1240x1240px. Infant wide-field retinal image — 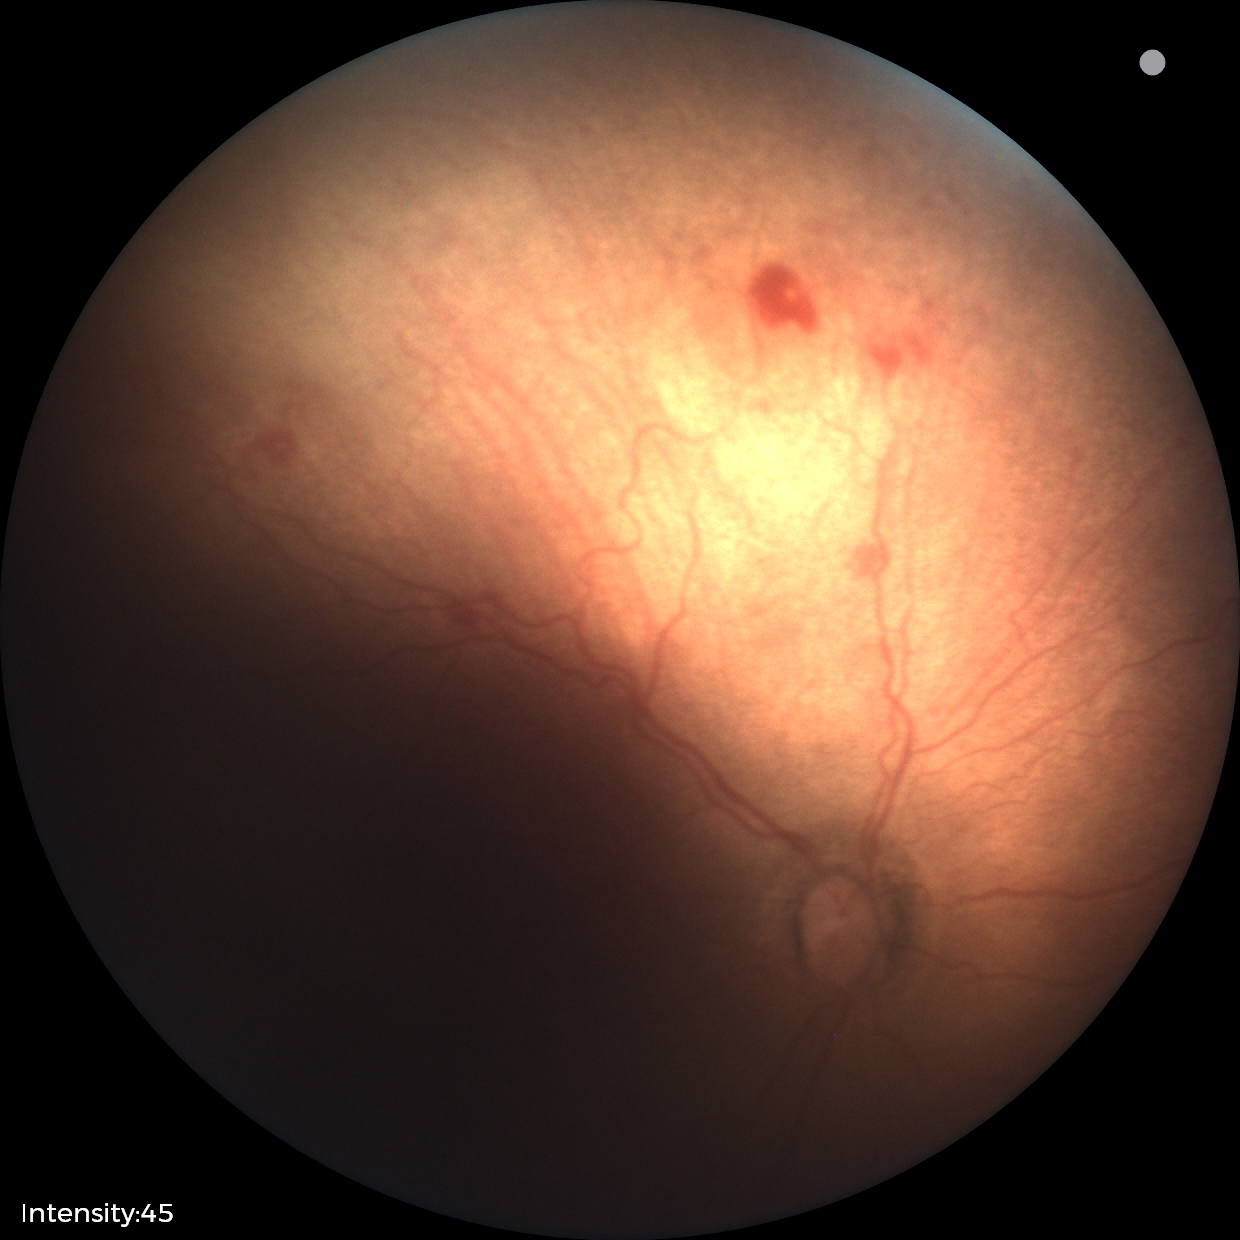
Impression: no plus disease; ROP stage 1.